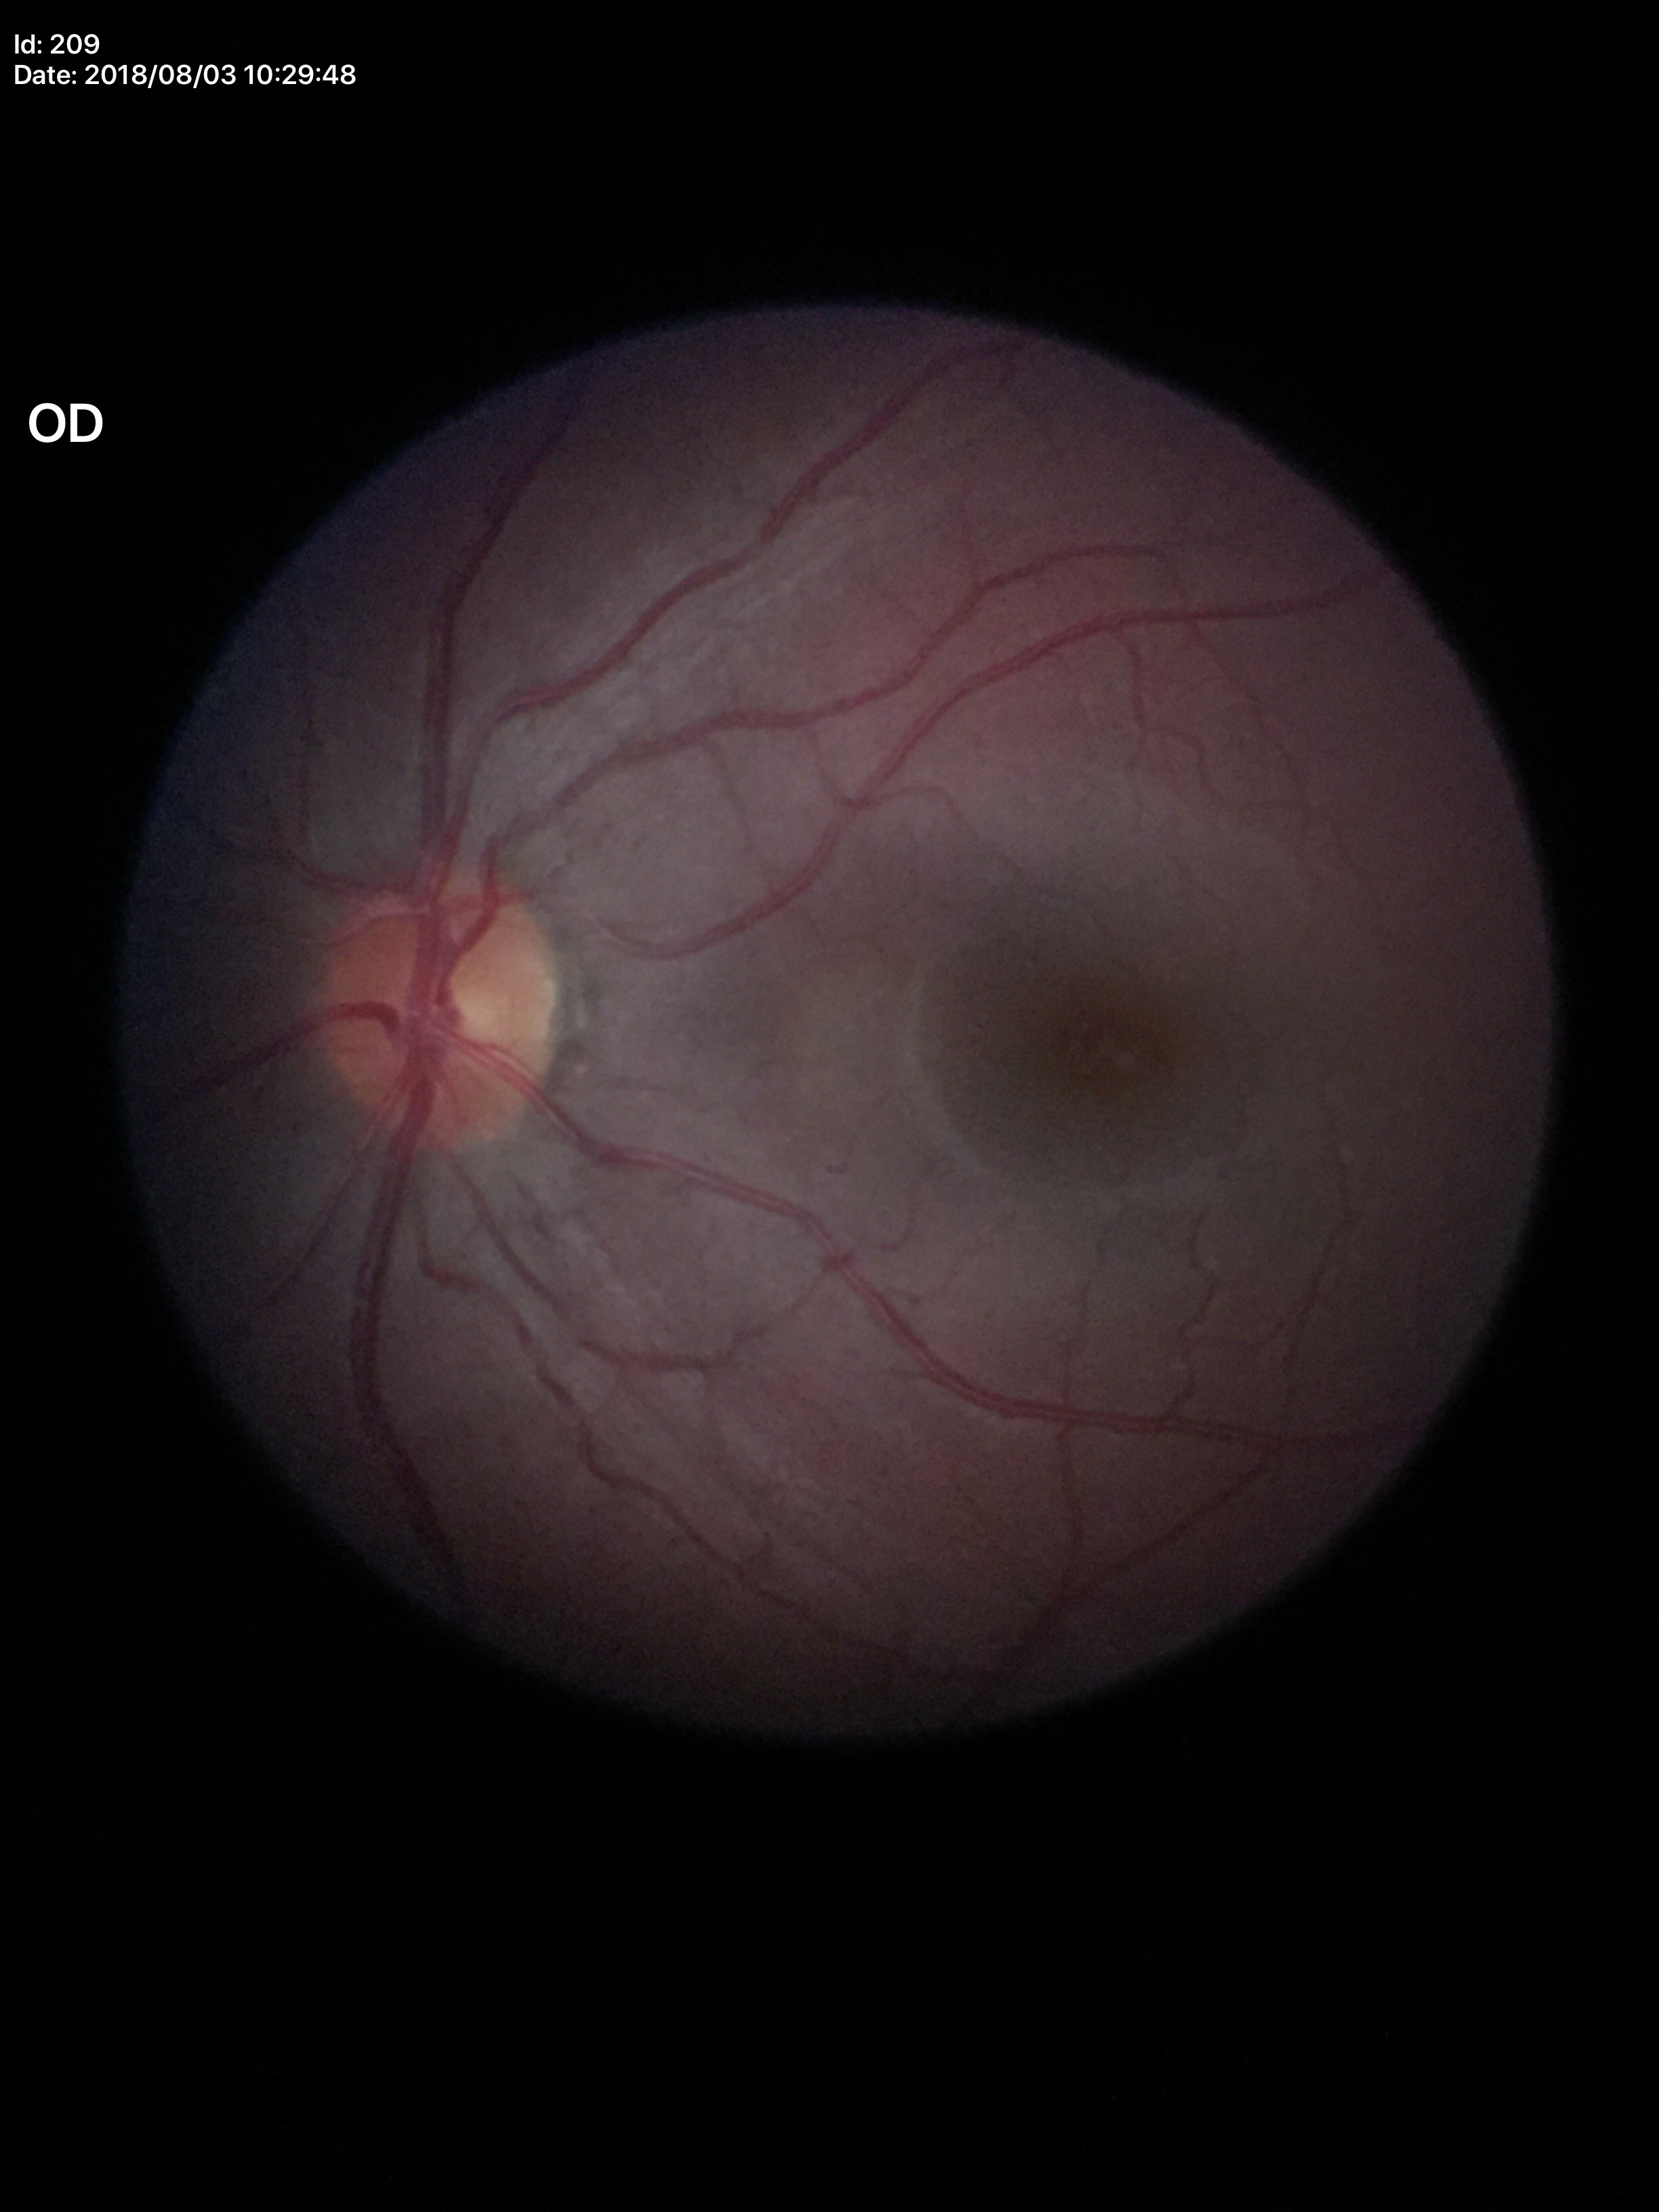 VCDR of 0.31. Not suspicious for glaucoma. HCDR: 0.38.